Image size 2212x1659, 45-degree field of view — 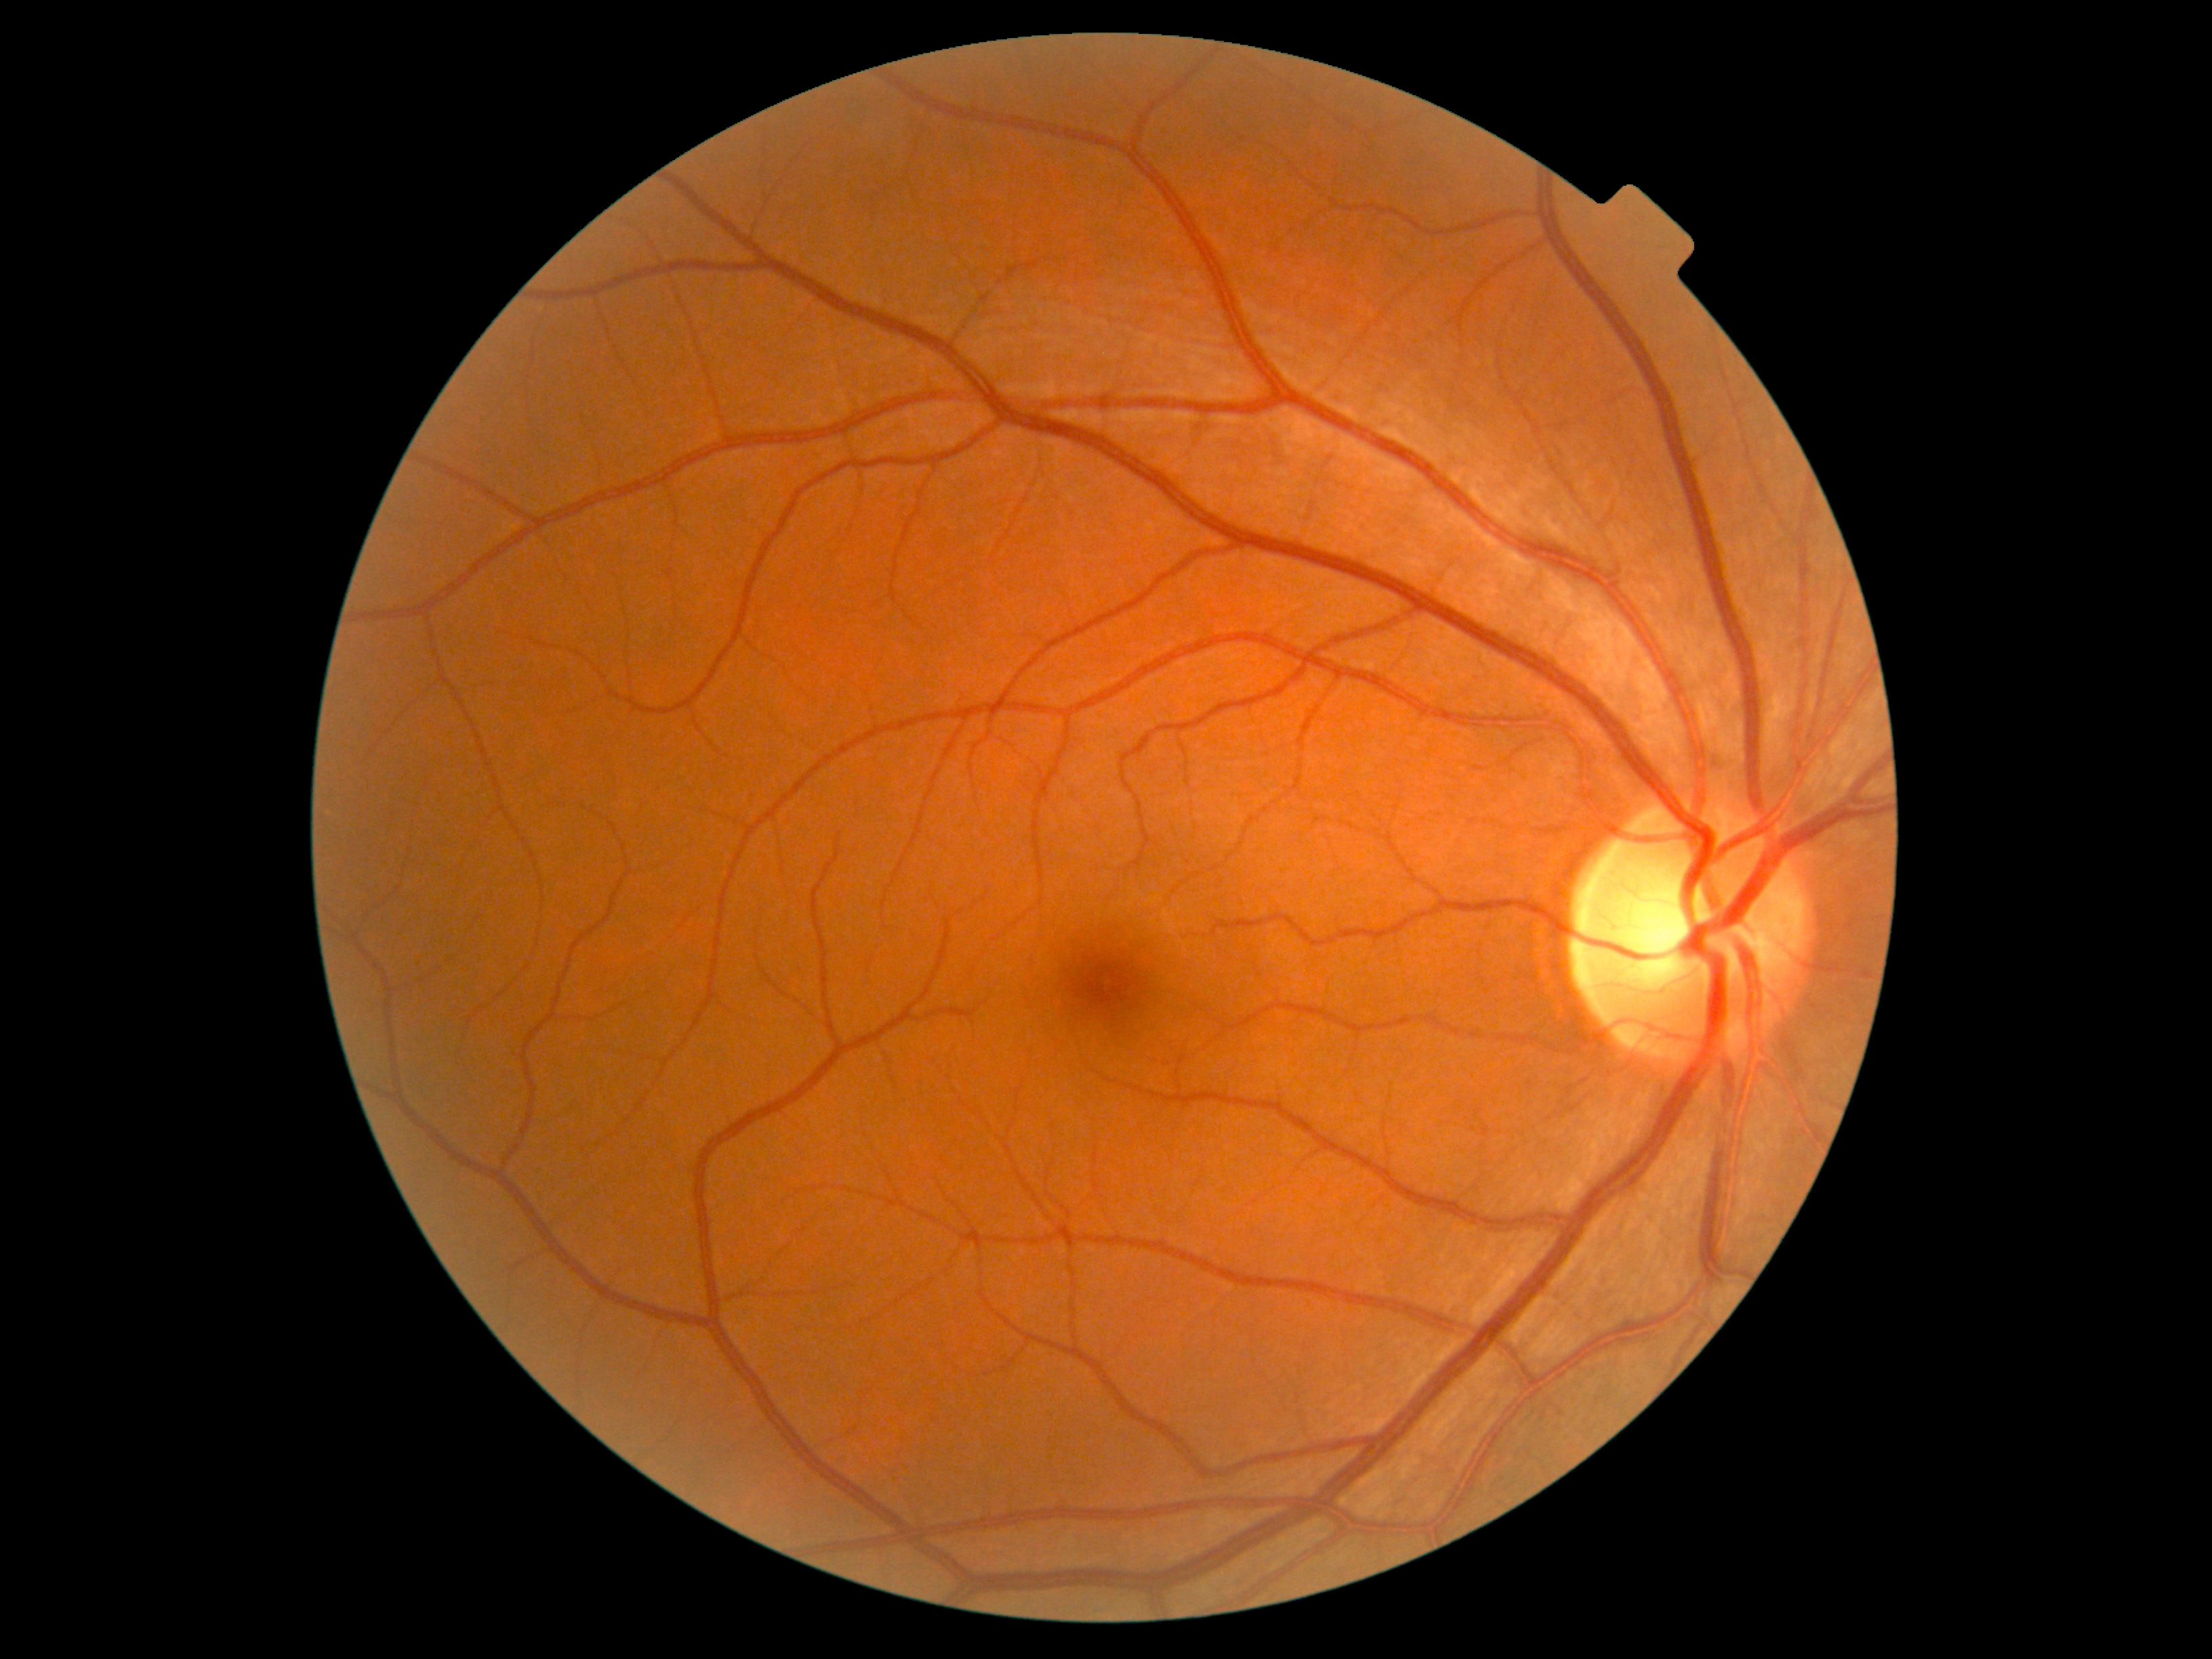

Retinopathy grade is no apparent retinopathy (0). No signs of diabetic retinopathy.